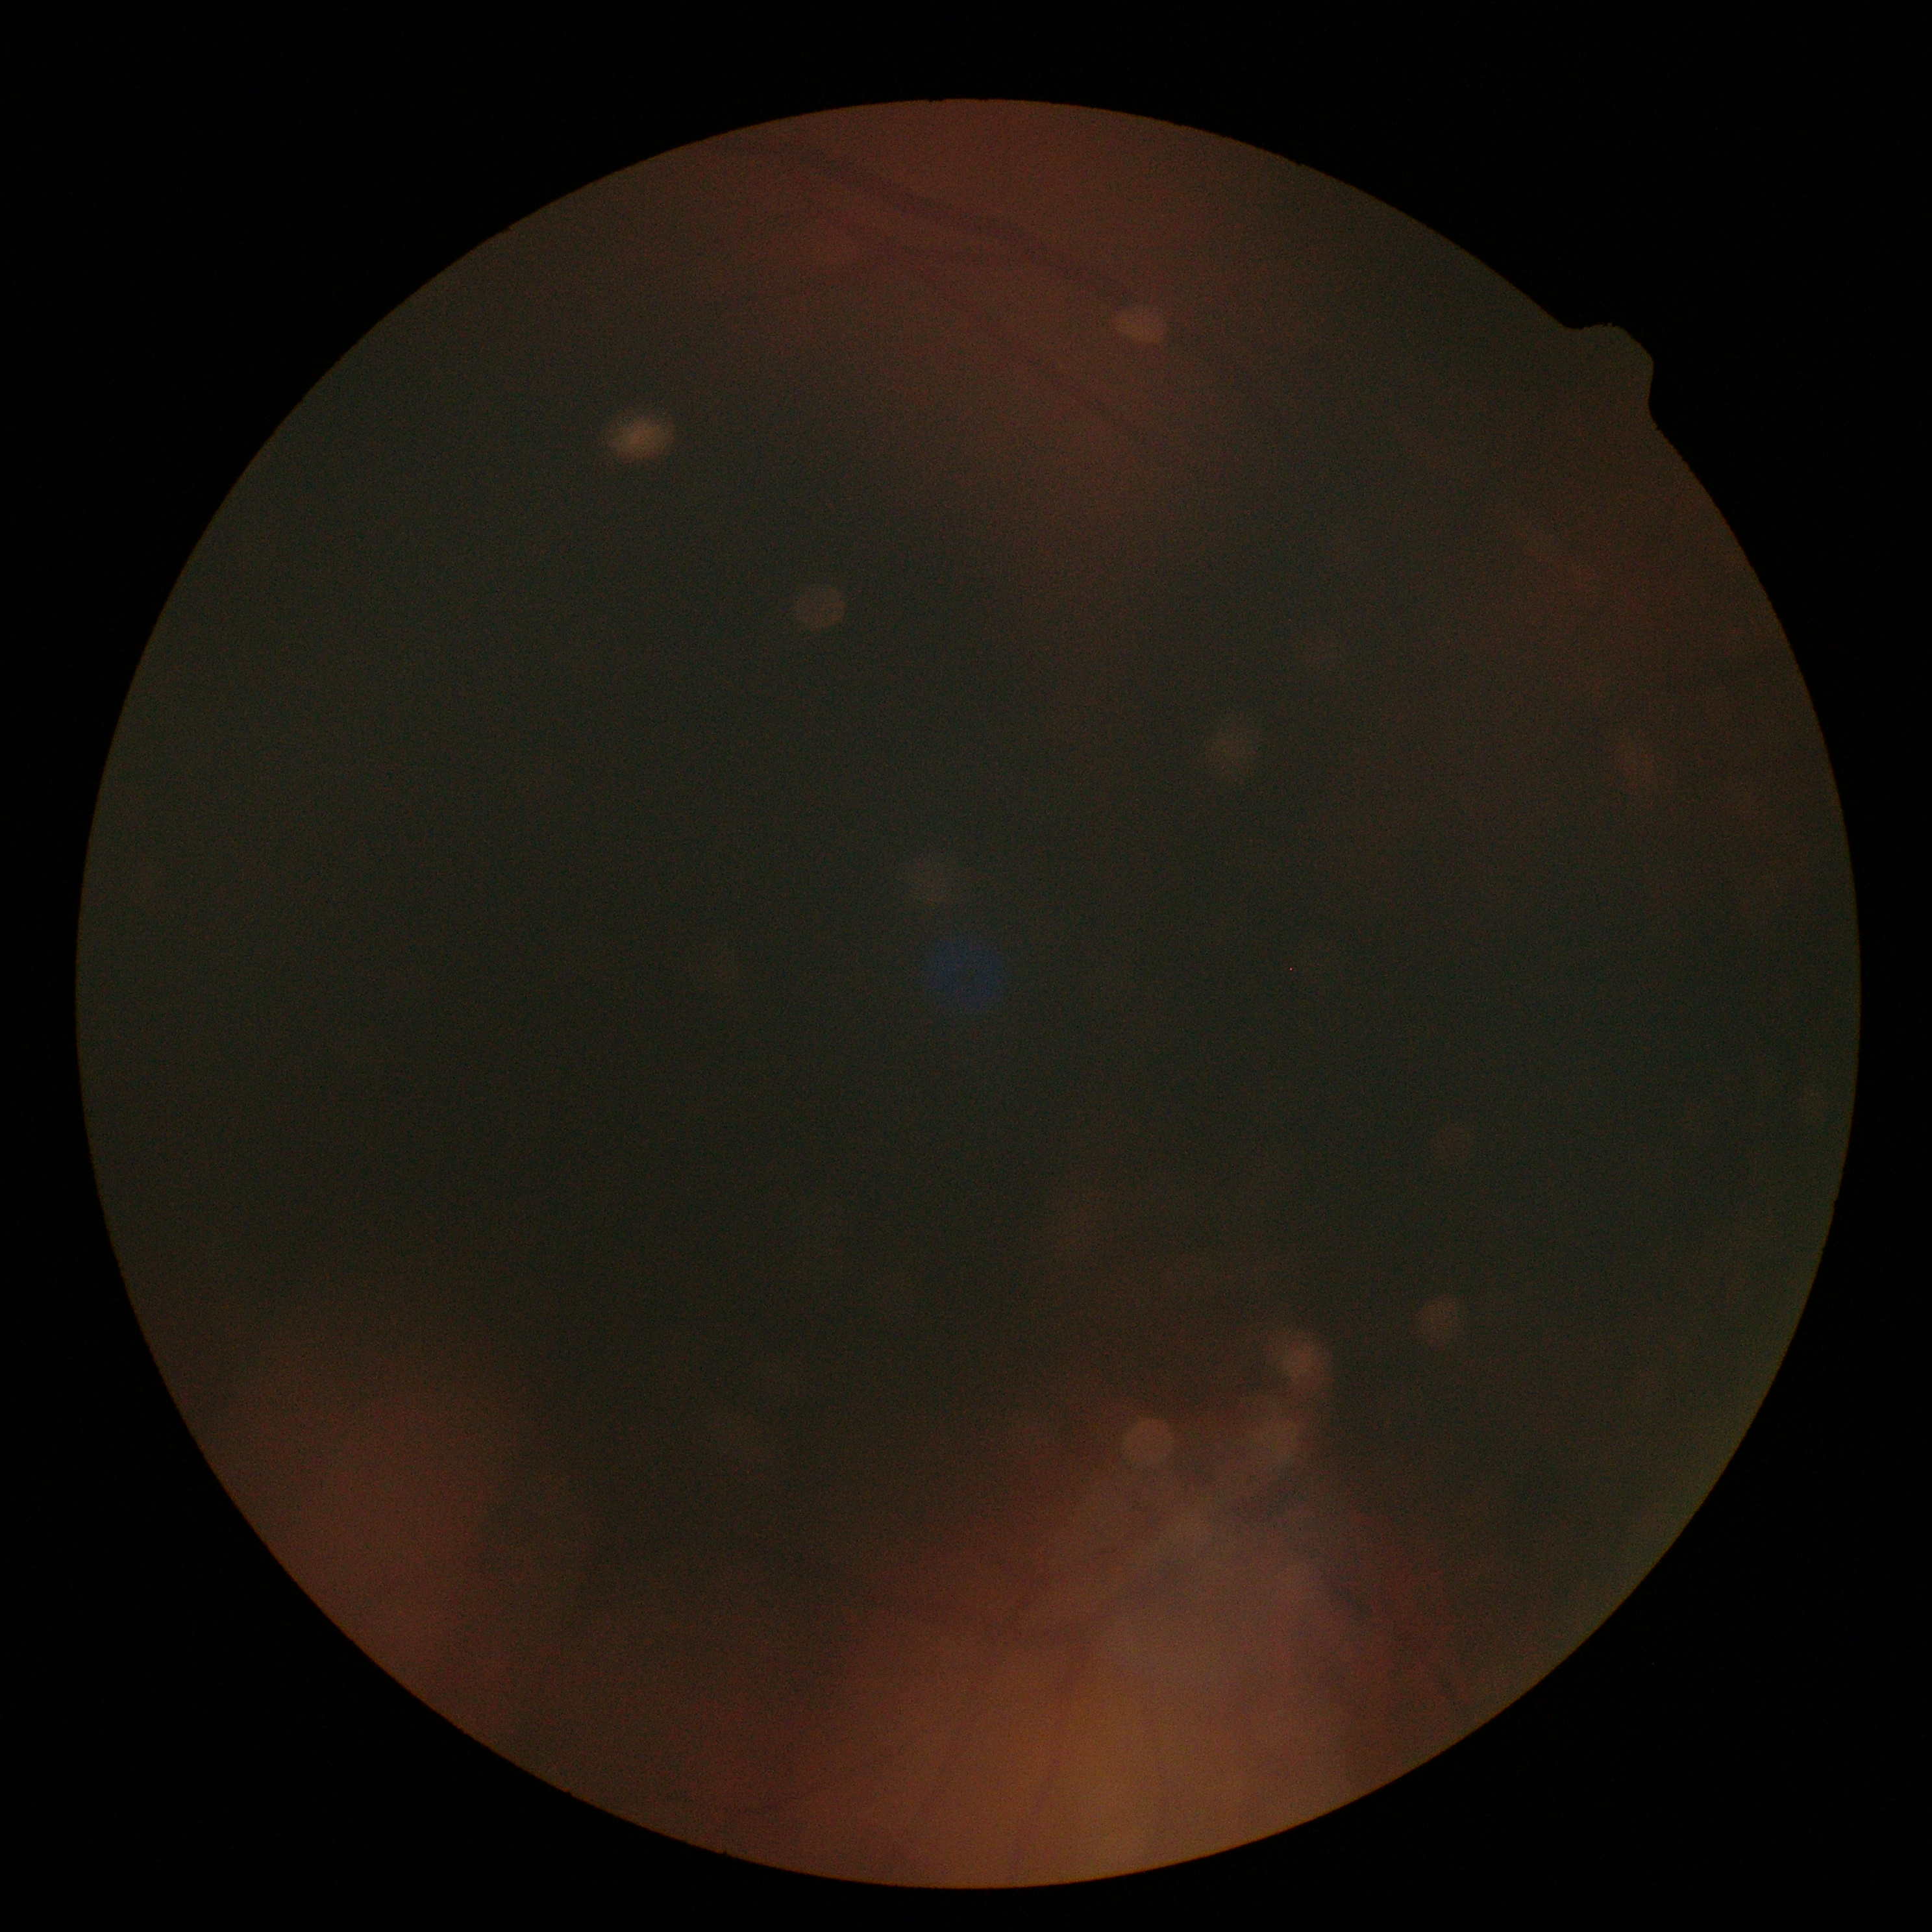 DR stage: ungradable.
Quality too poor to assess for DR.